45-degree field of view, Davis DR grading, 848x848px — 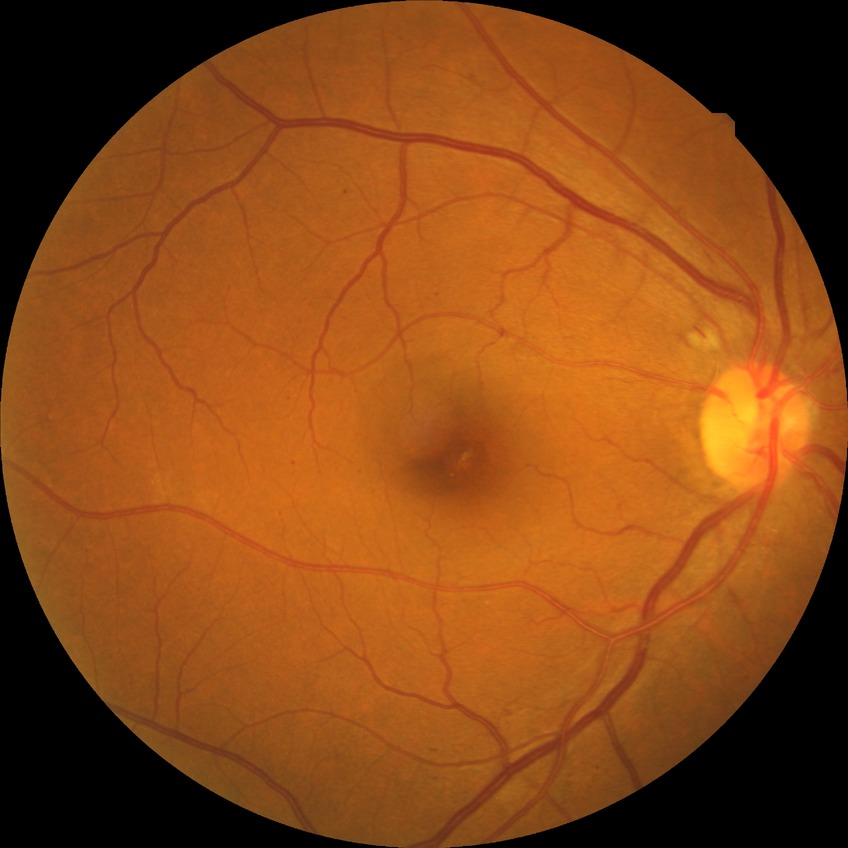

diabetic retinopathy (DR)=SDR (simple diabetic retinopathy).